Posterior pole color fundus photograph; DR severity per modified Davis staging; camera: NIDEK AFC-230
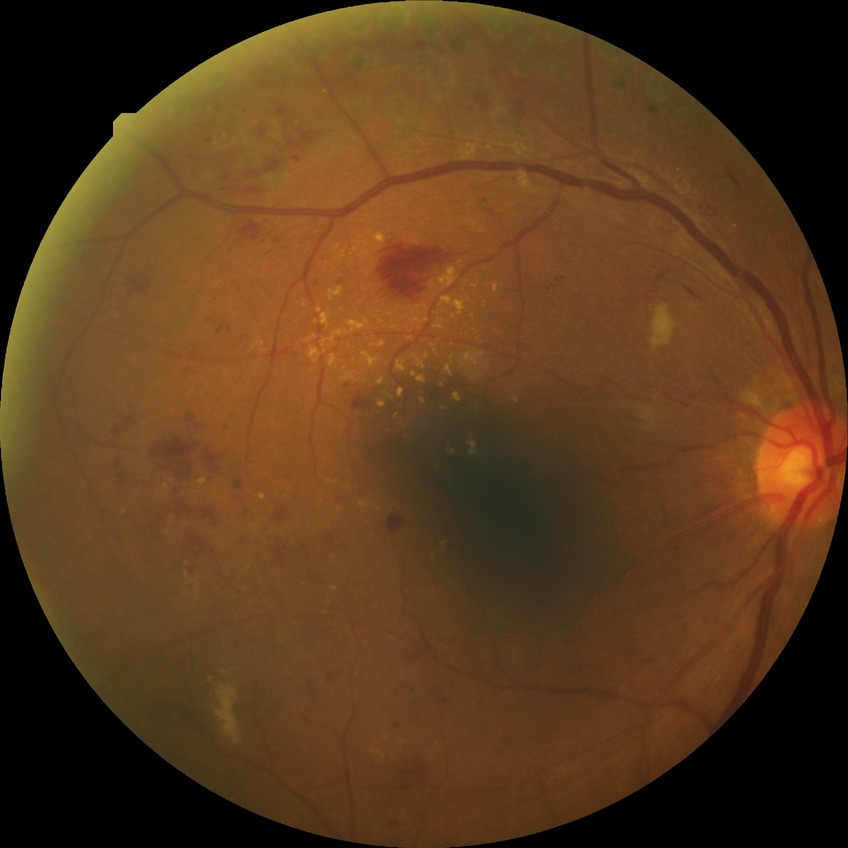 – diabetic retinopathy (DR) — proliferative diabetic retinopathy (PDR)